Wide-field fundus image from infant ROP screening; 1440 by 1080 pixels.
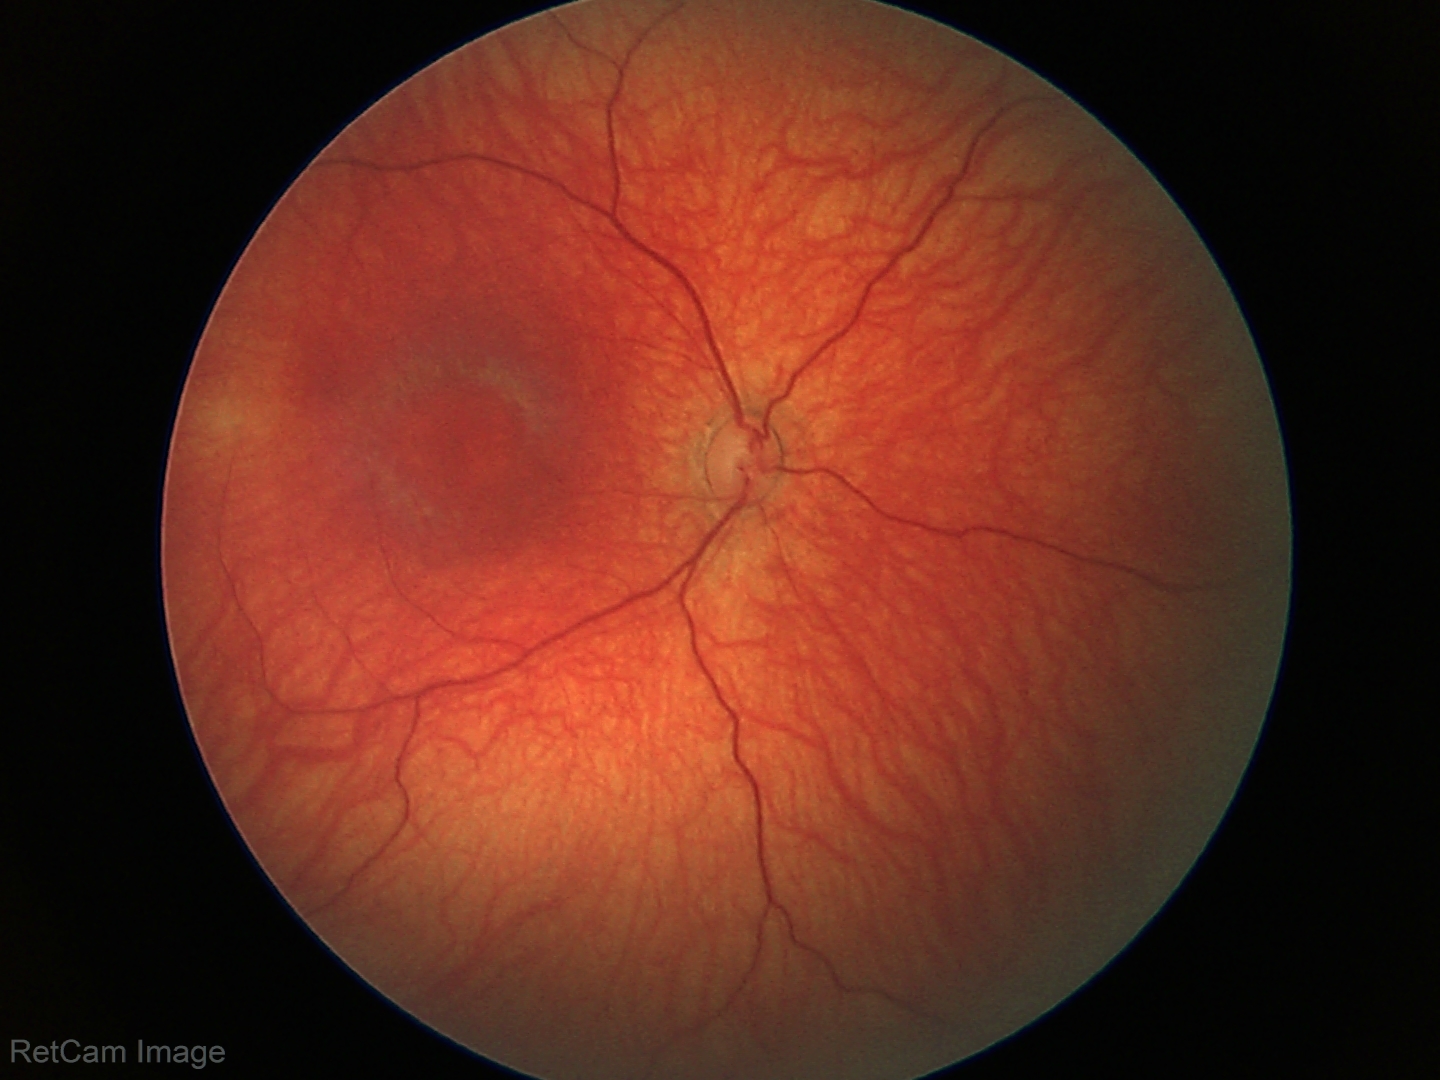
Screening examination diagnosed as physiological.